Fundus photo; 45-degree field of view: 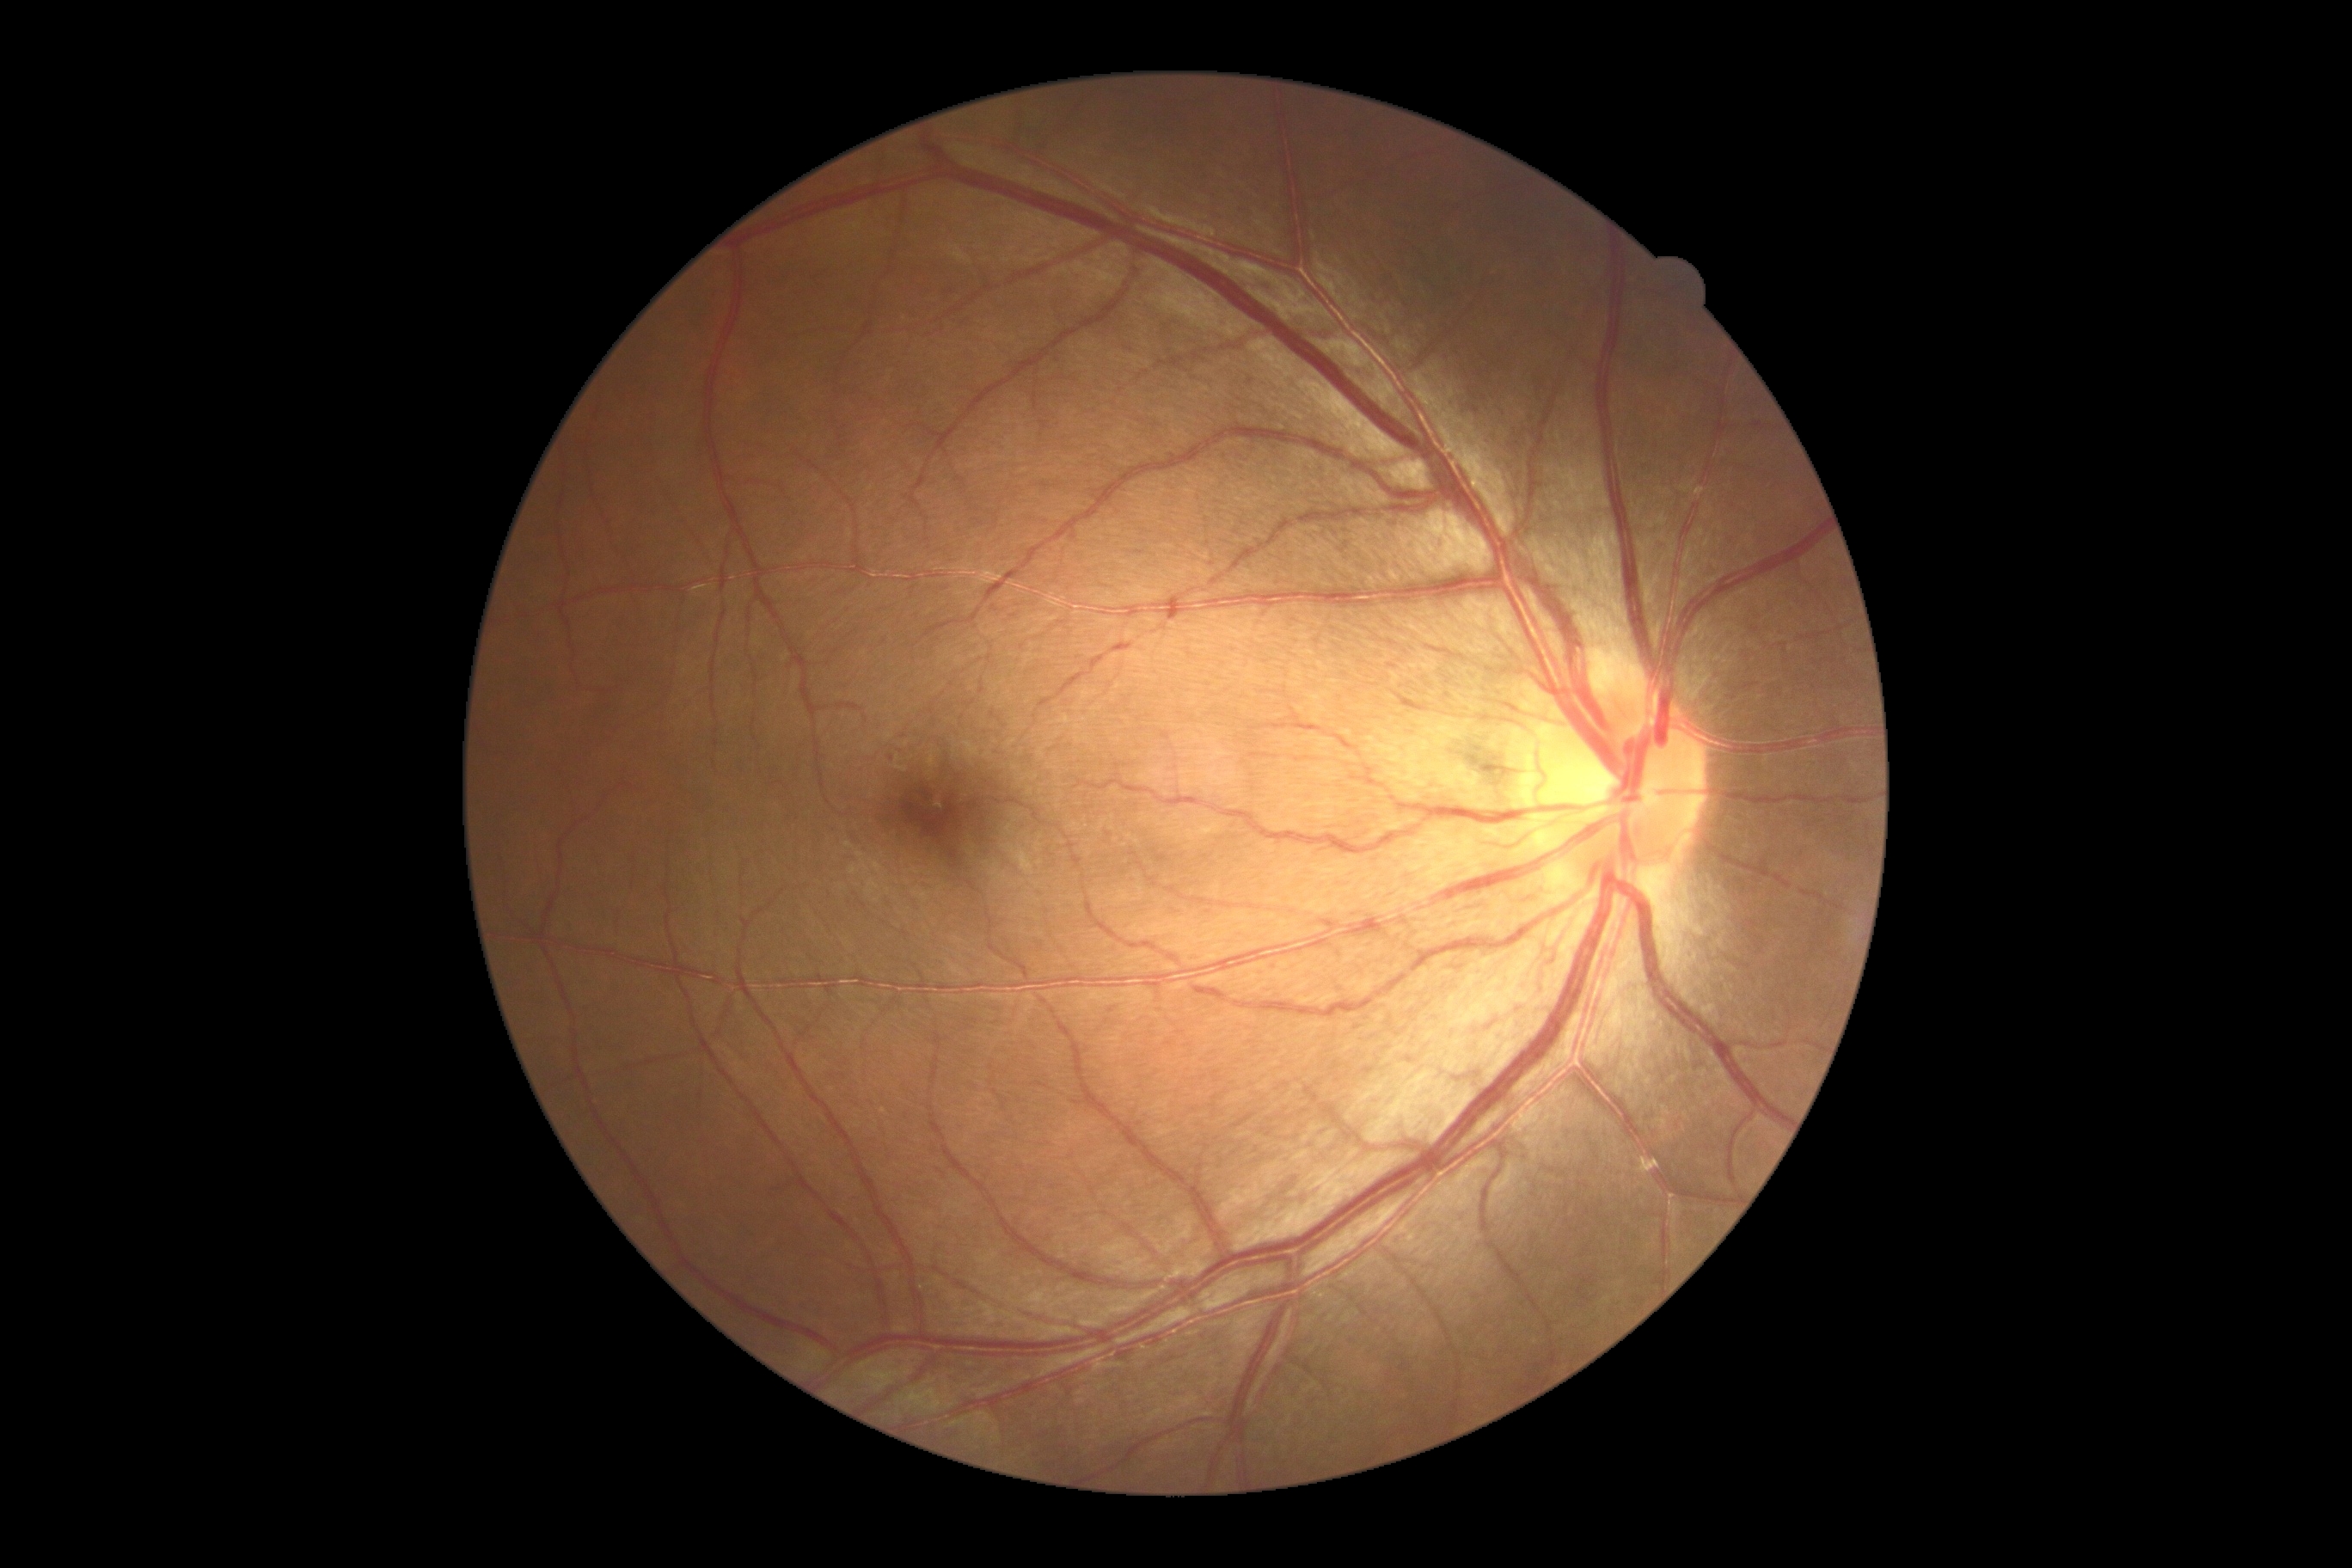

Diabetic retinopathy (DR) is grade 1 — presence of microaneurysms only.